848x848px.
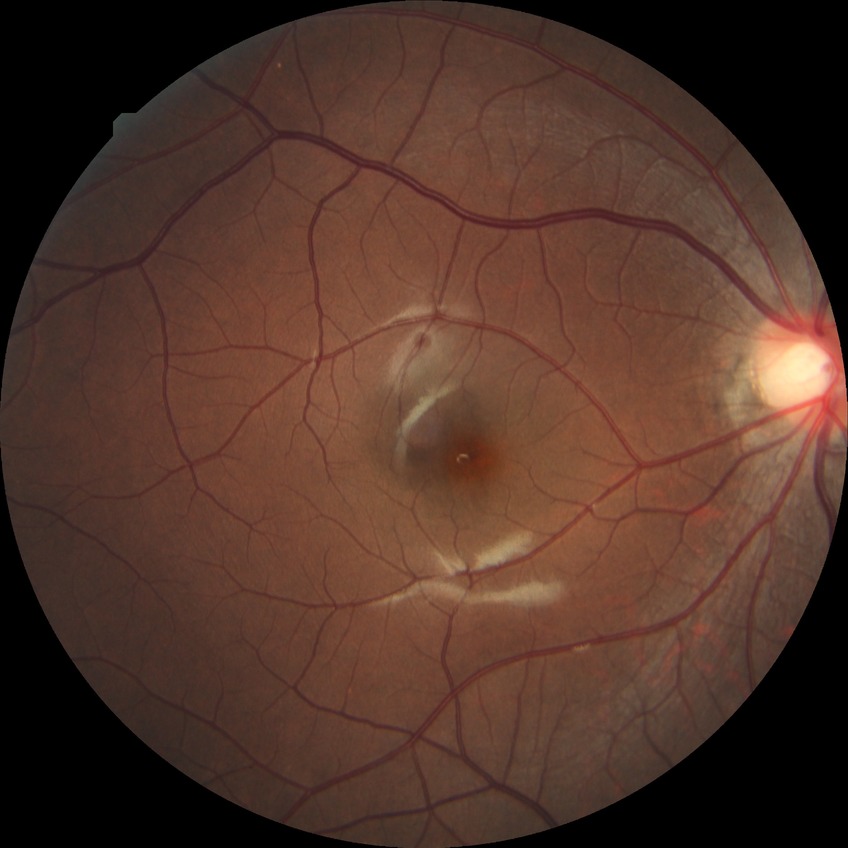

Davis grading is no diabetic retinopathy.